DR severity per modified Davis staging:
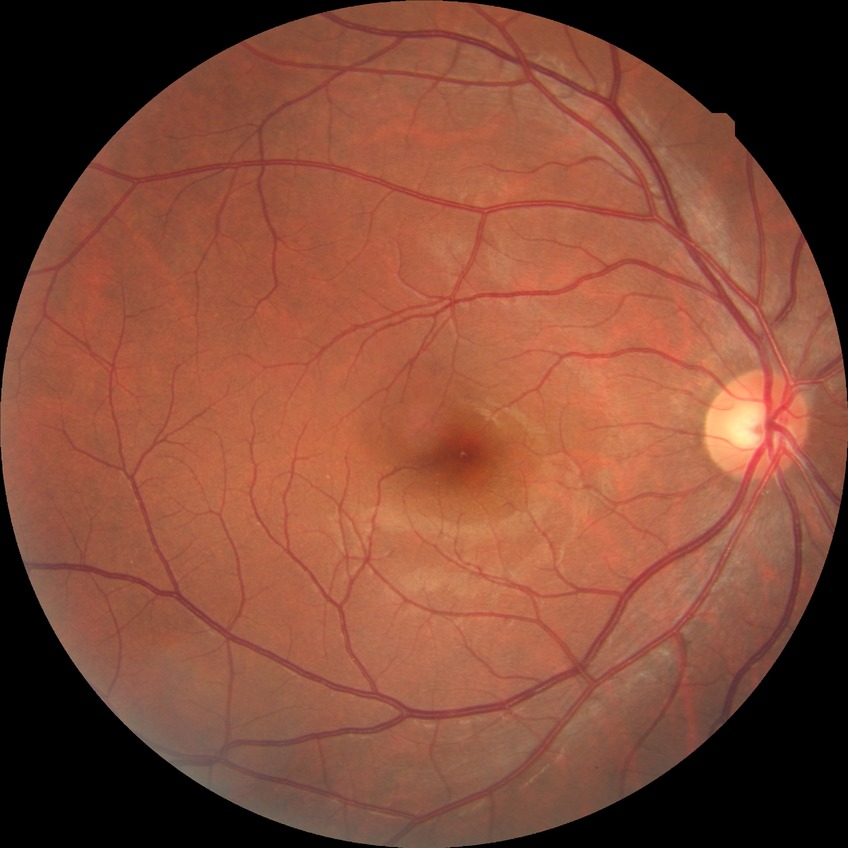
  davis_grade: no diabetic retinopathy (NDR)